Posterior pole view:
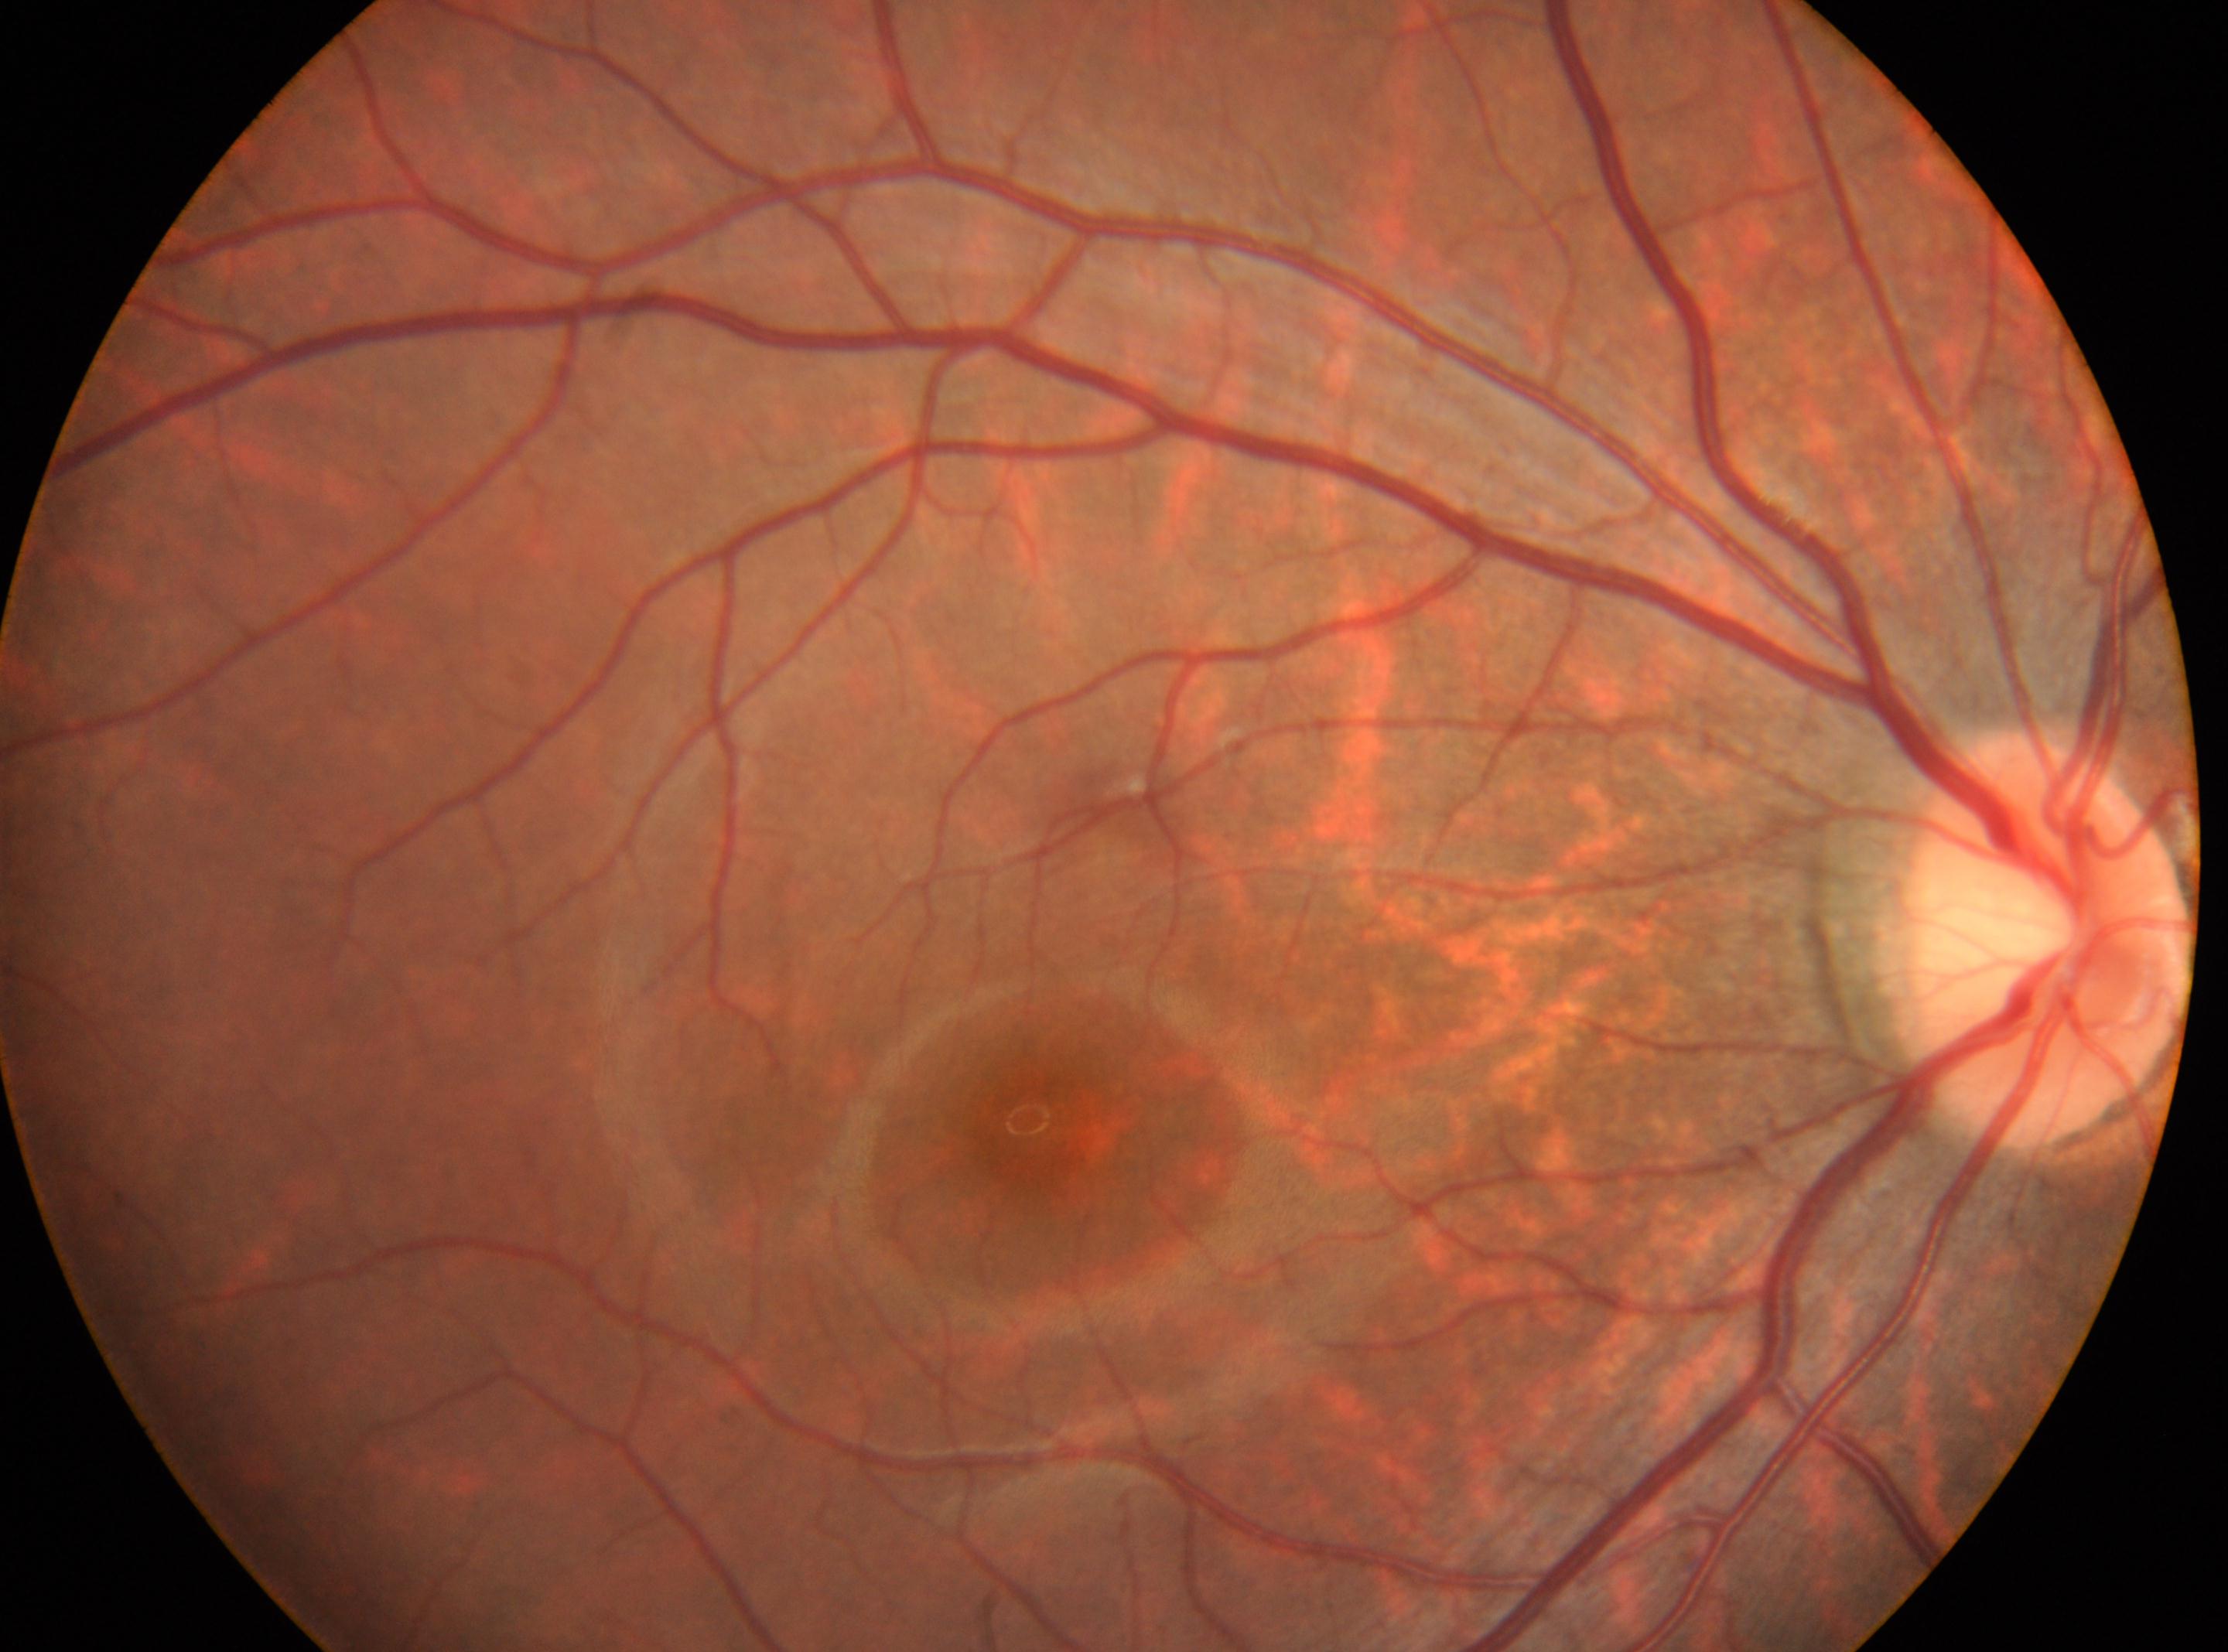

diabetic retinopathy severity: 0, macula center: (x: 1030, y: 1131), laterality: oculus dexter, disc center: (x: 2045, y: 940), DR impression: No diabetic retinopathy identified.